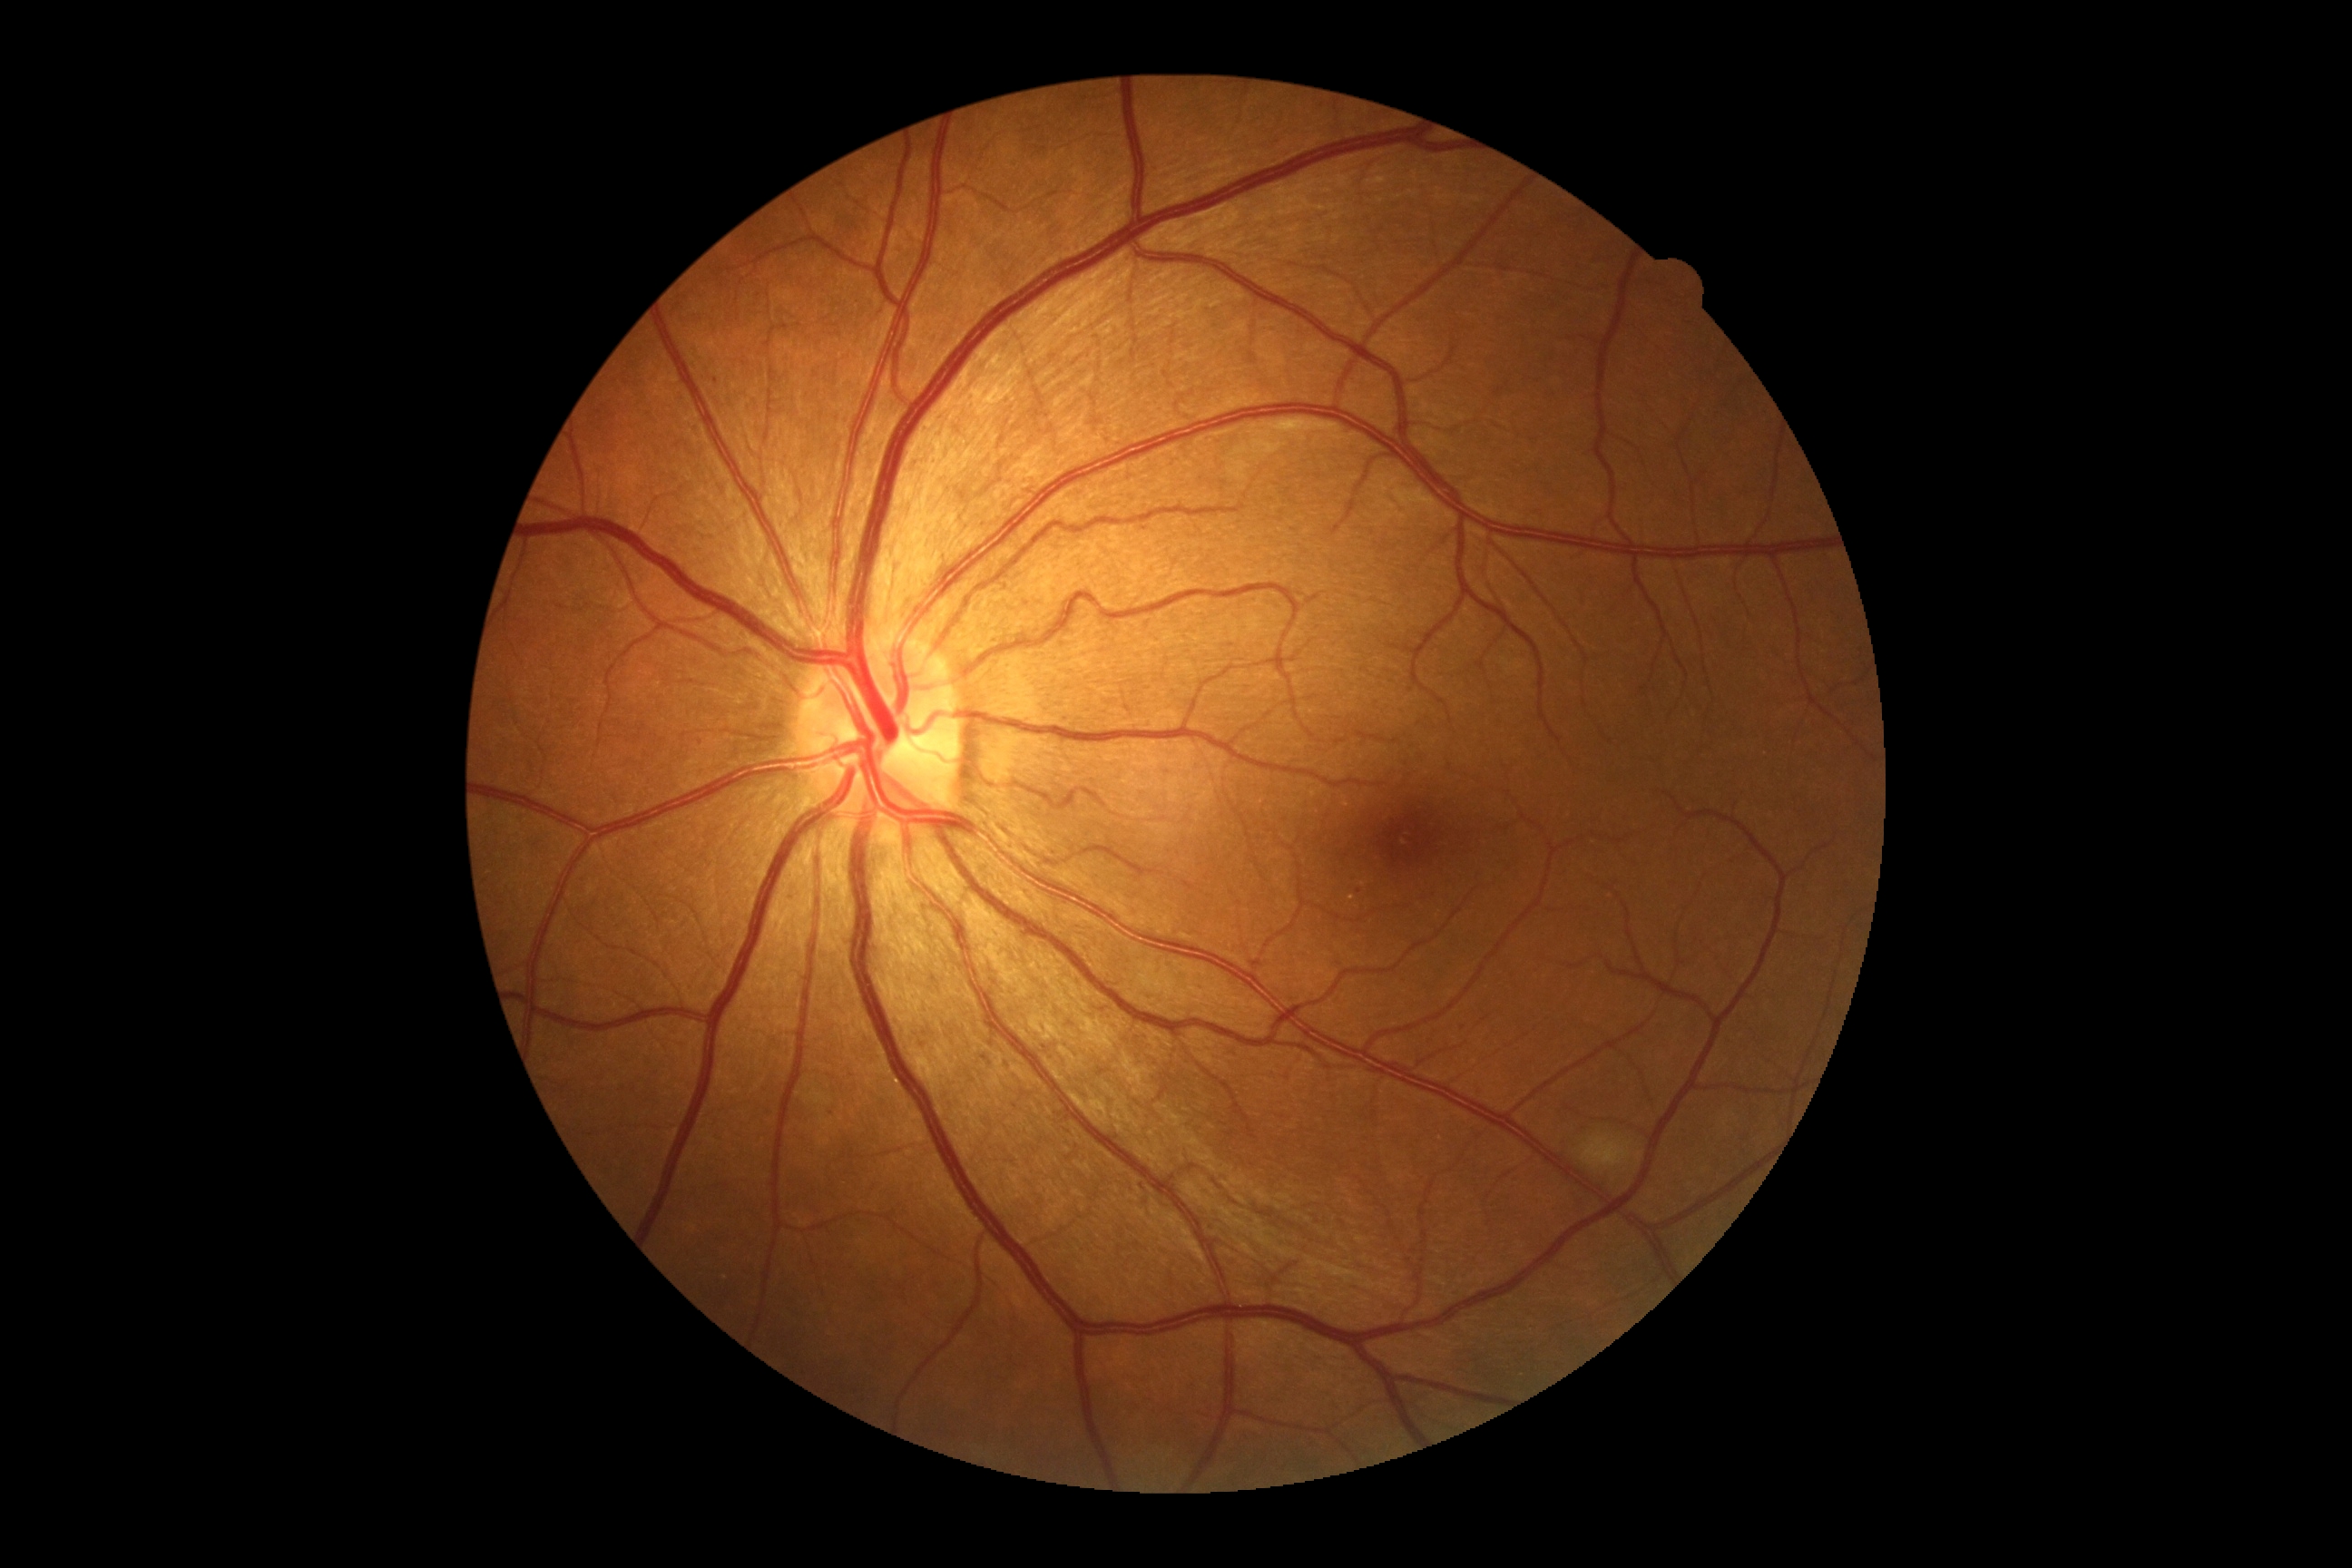

retinopathy=grade 2.